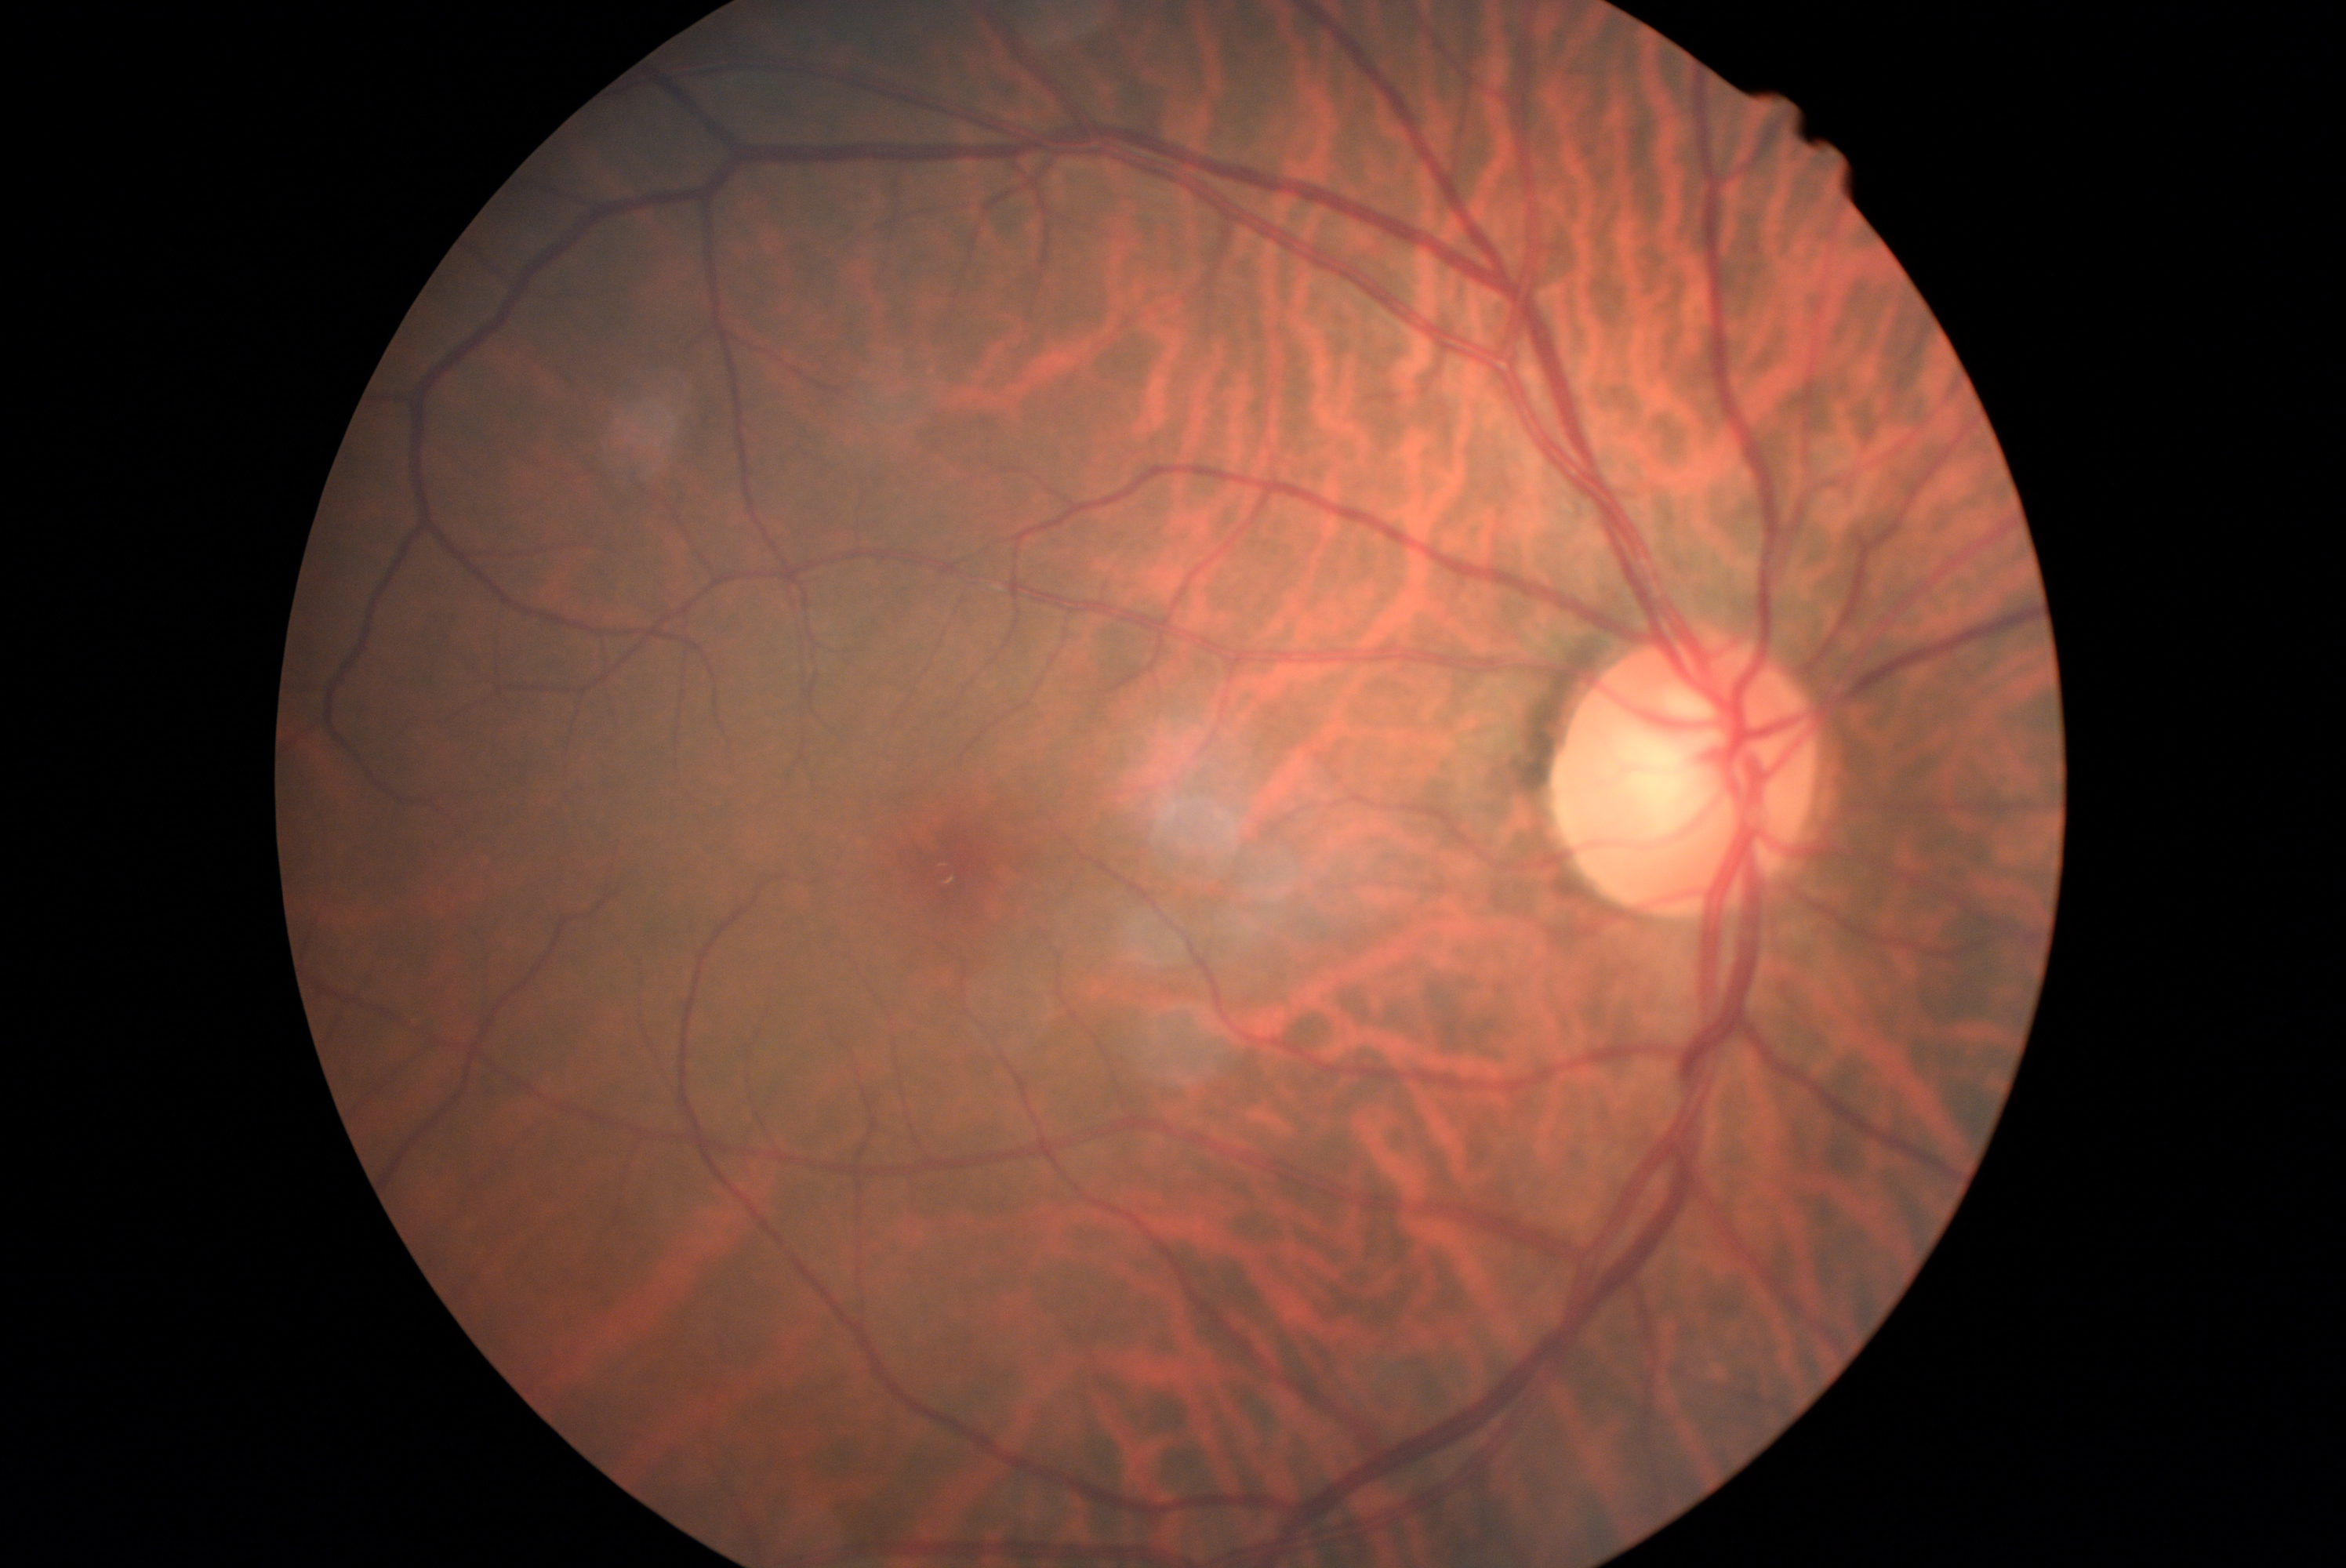 diabetic retinopathy (DR): 0.